CFP — 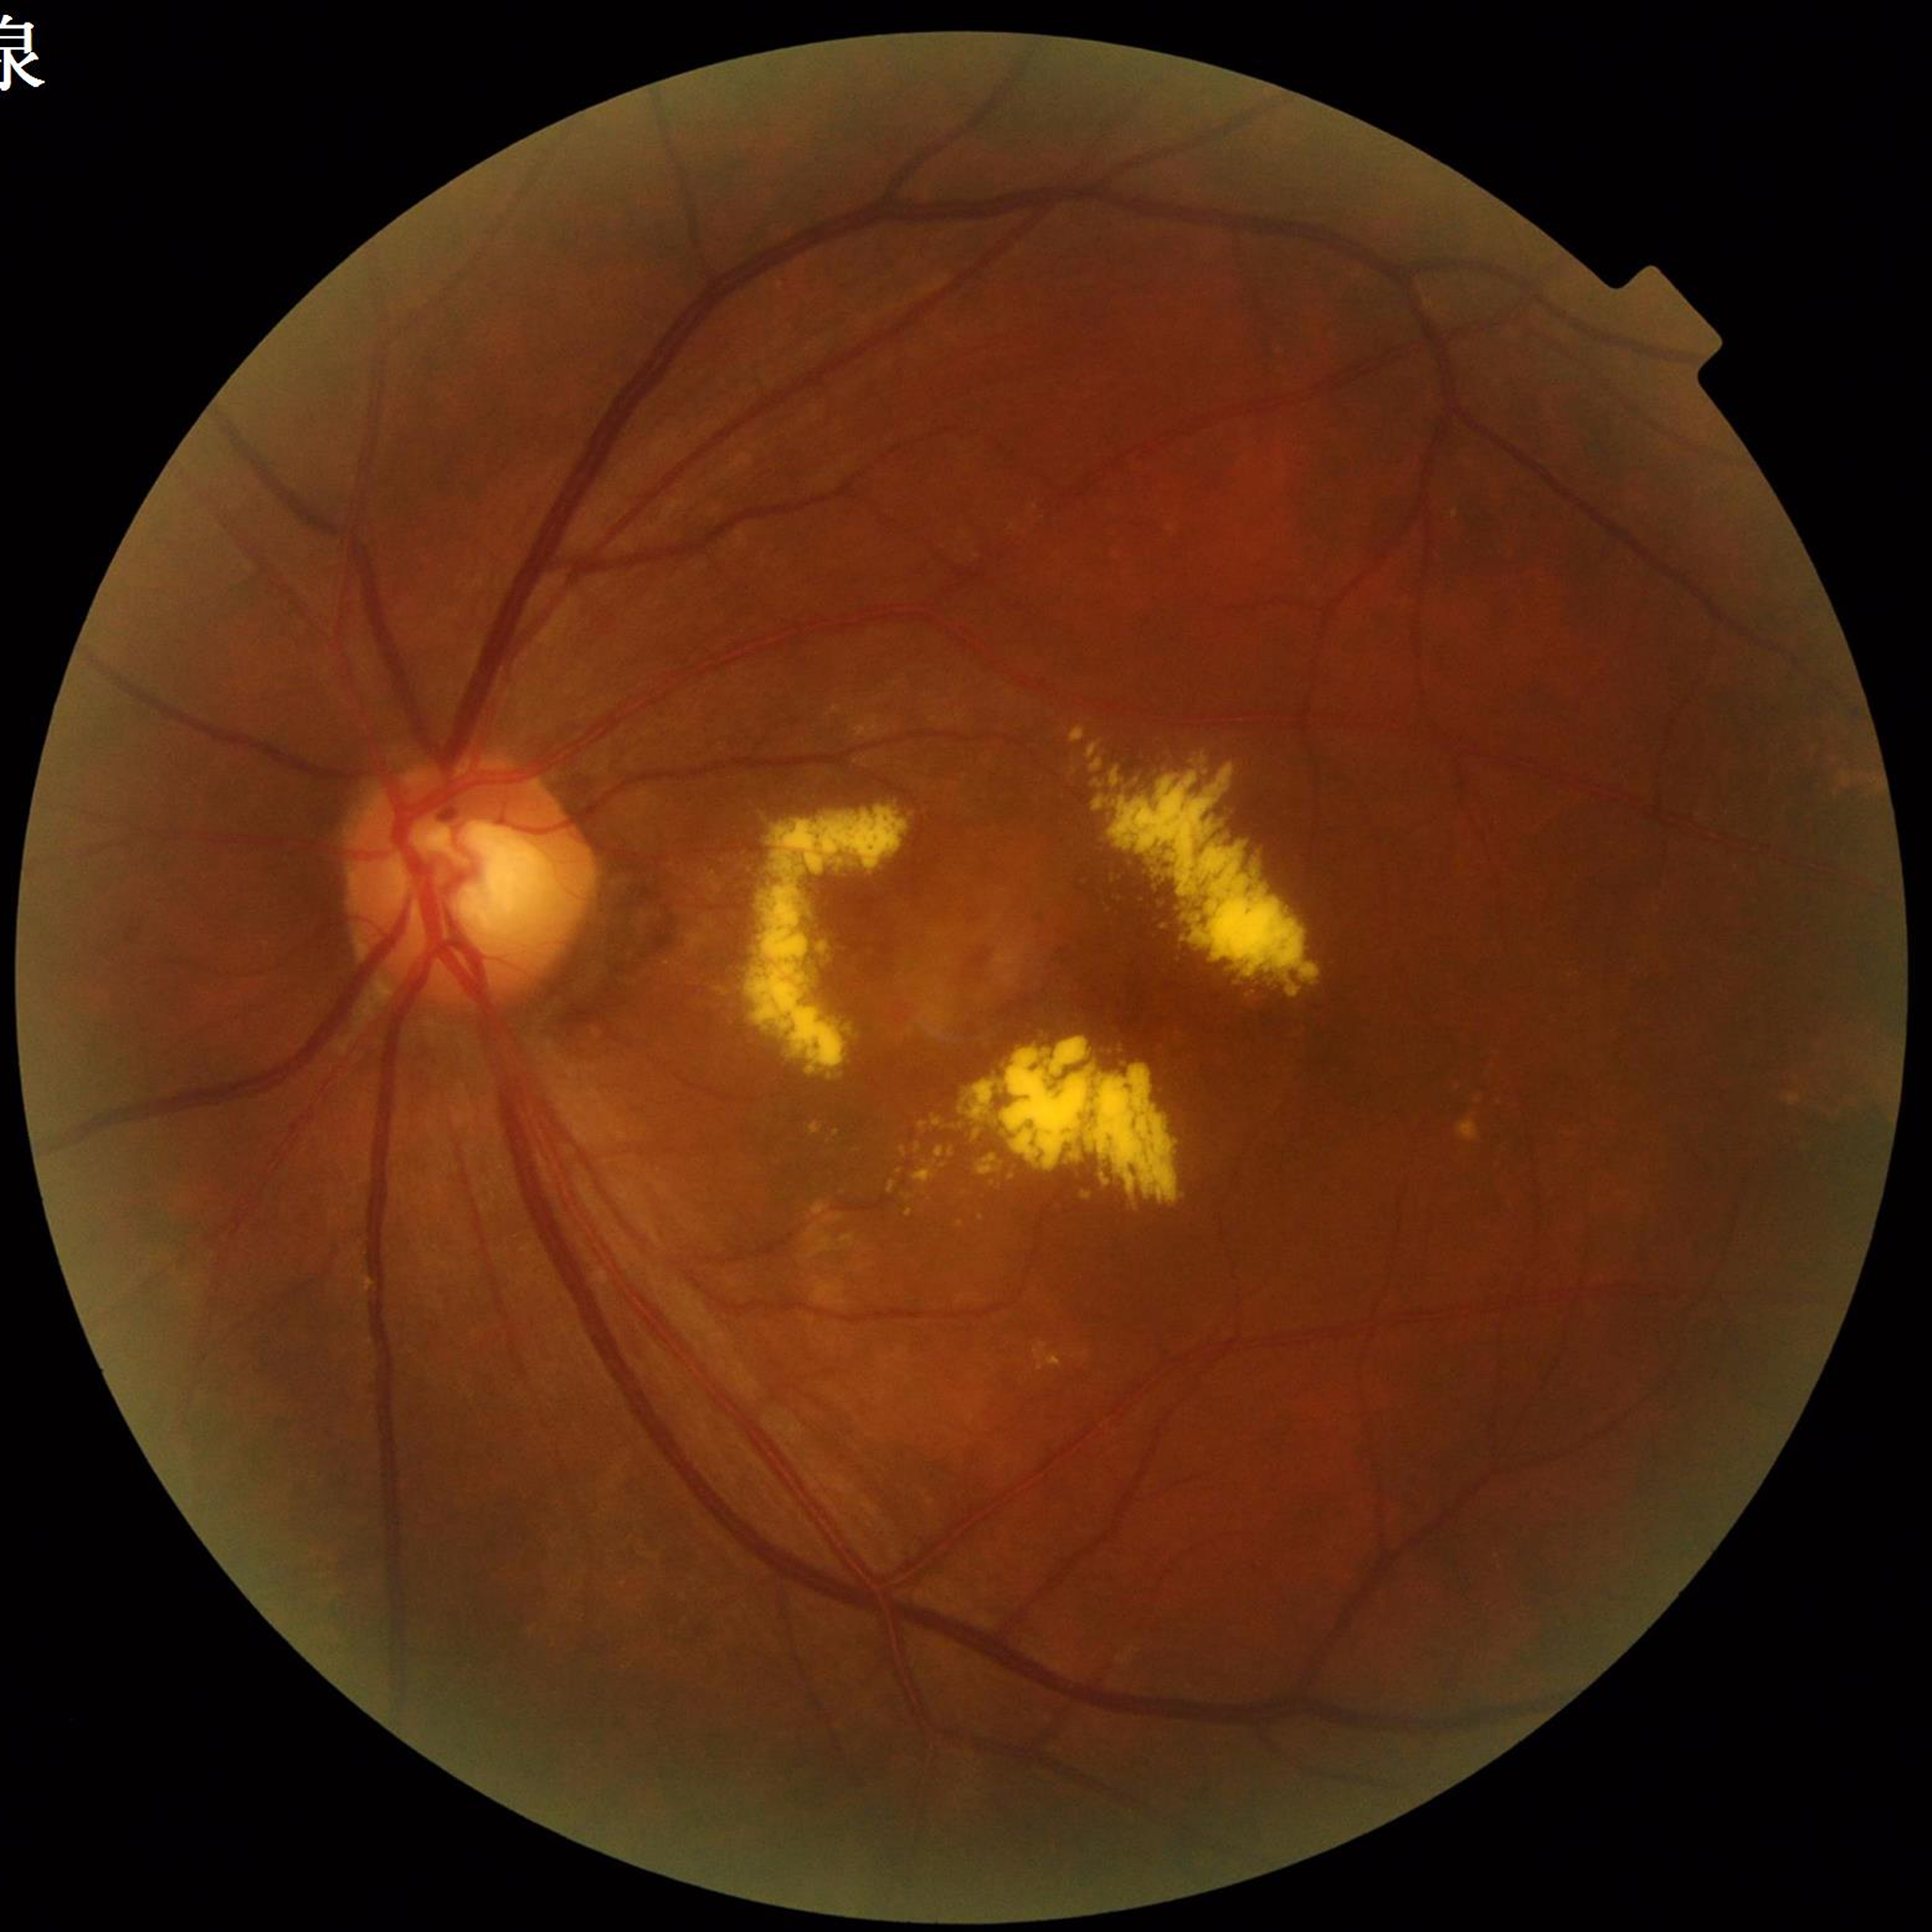 Quality assessment: satisfactory.
Eye affected by age-related macular degeneration.